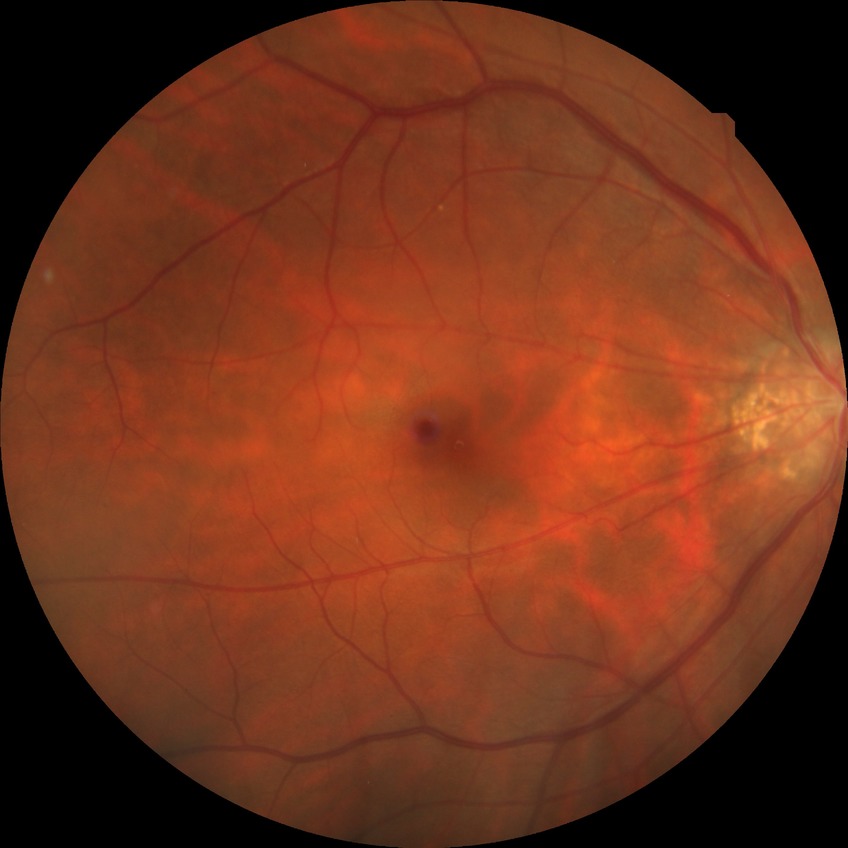
  davis_grade: no diabetic retinopathy